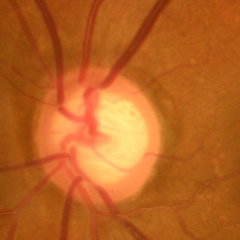 Glaucoma assessment: early glaucomatous changes.